1932x1932, retinal fundus photograph, 45-degree field of view
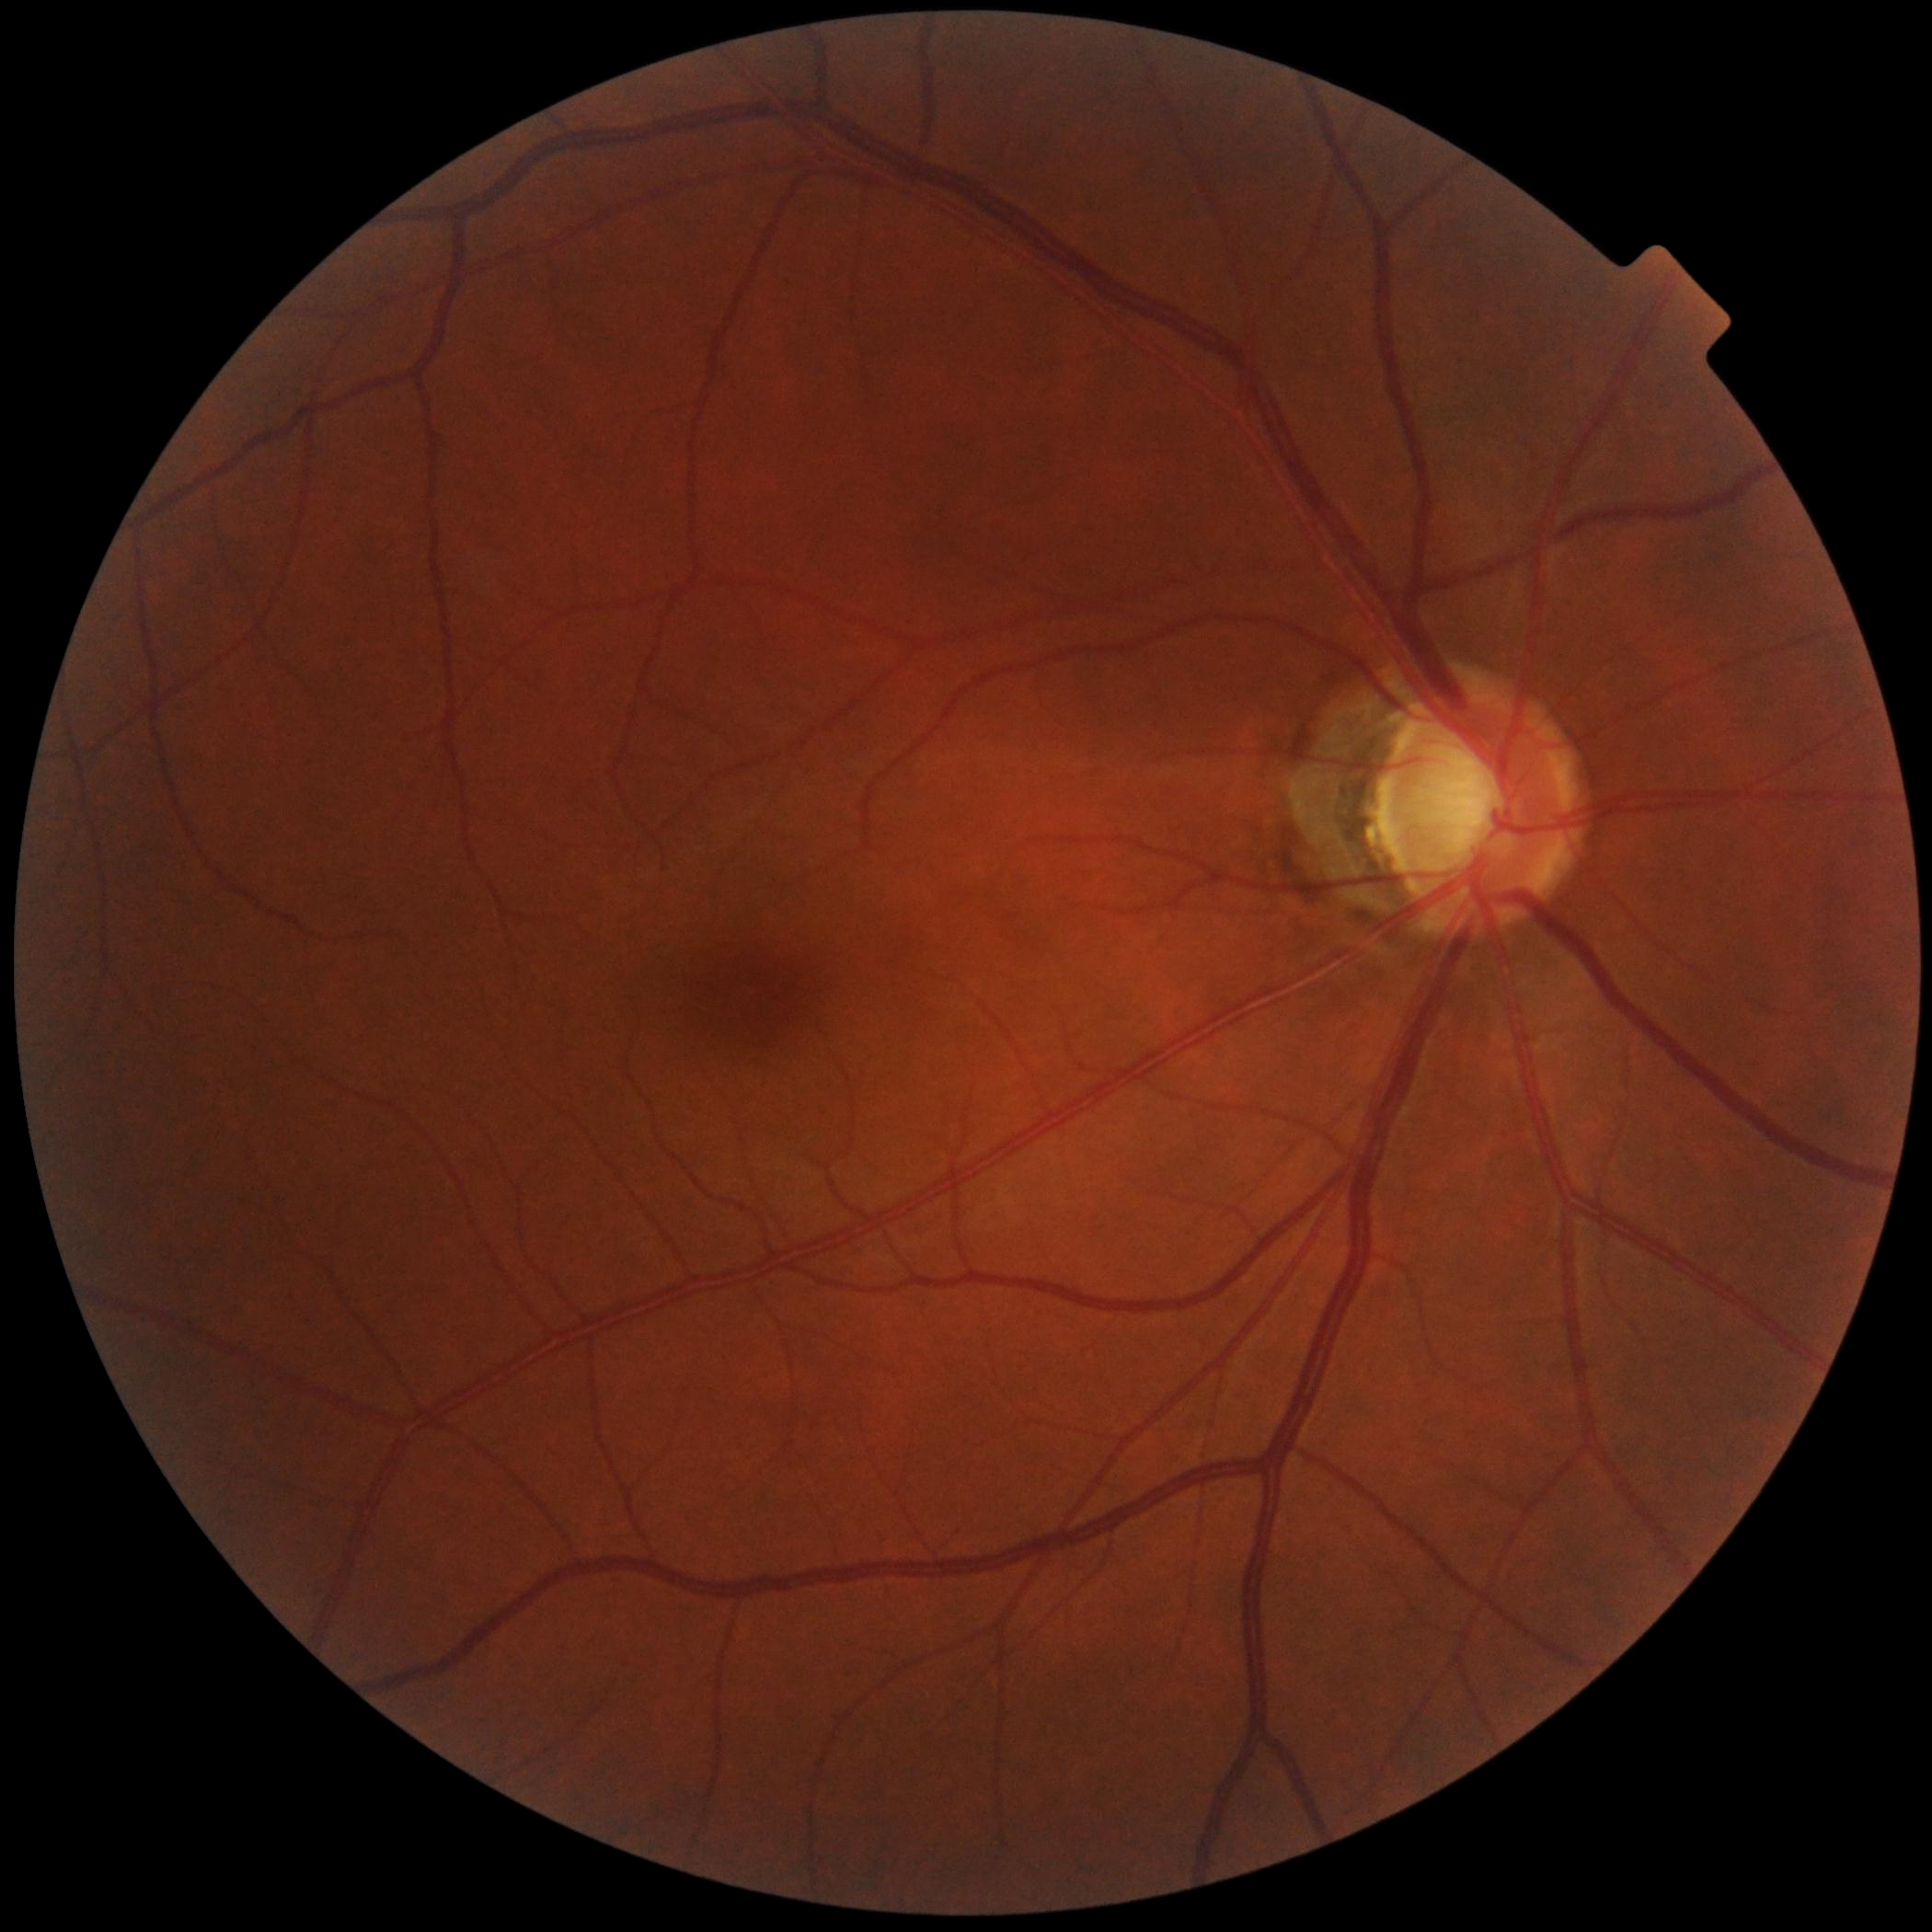
Diabetic retinopathy (DR) is grade 0 (no apparent retinopathy).